Optic disc region crop: 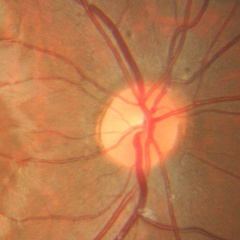 The image shows no glaucomatous changes.